CFP:
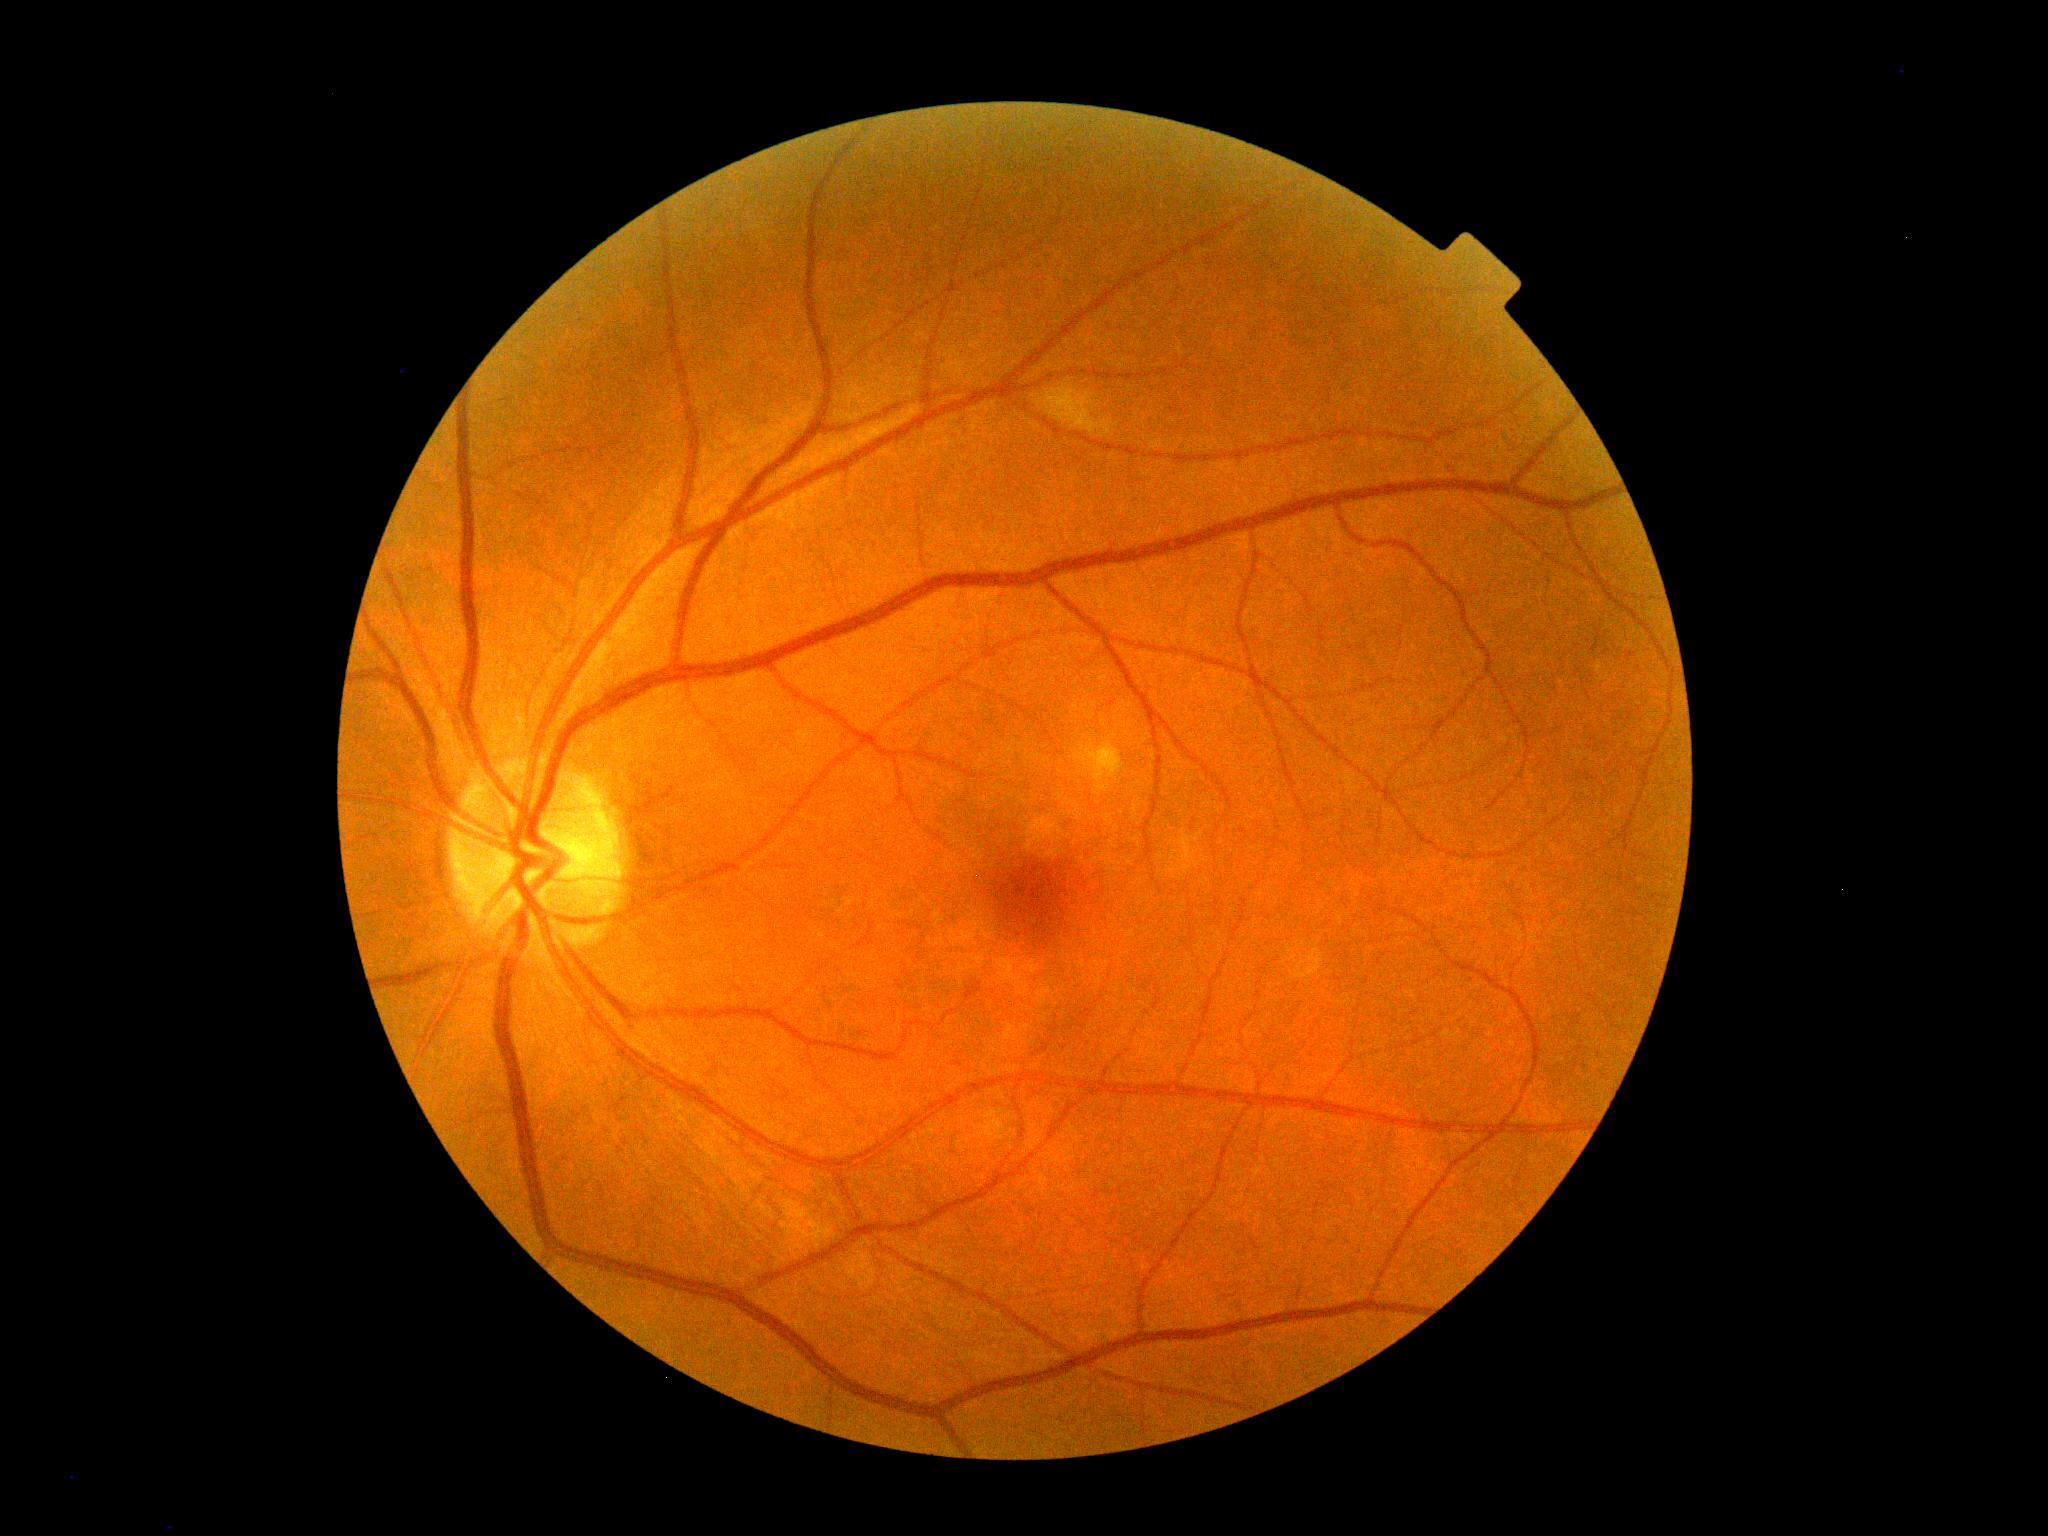

DR grade is 0 (no apparent retinopathy).